45° FOV:
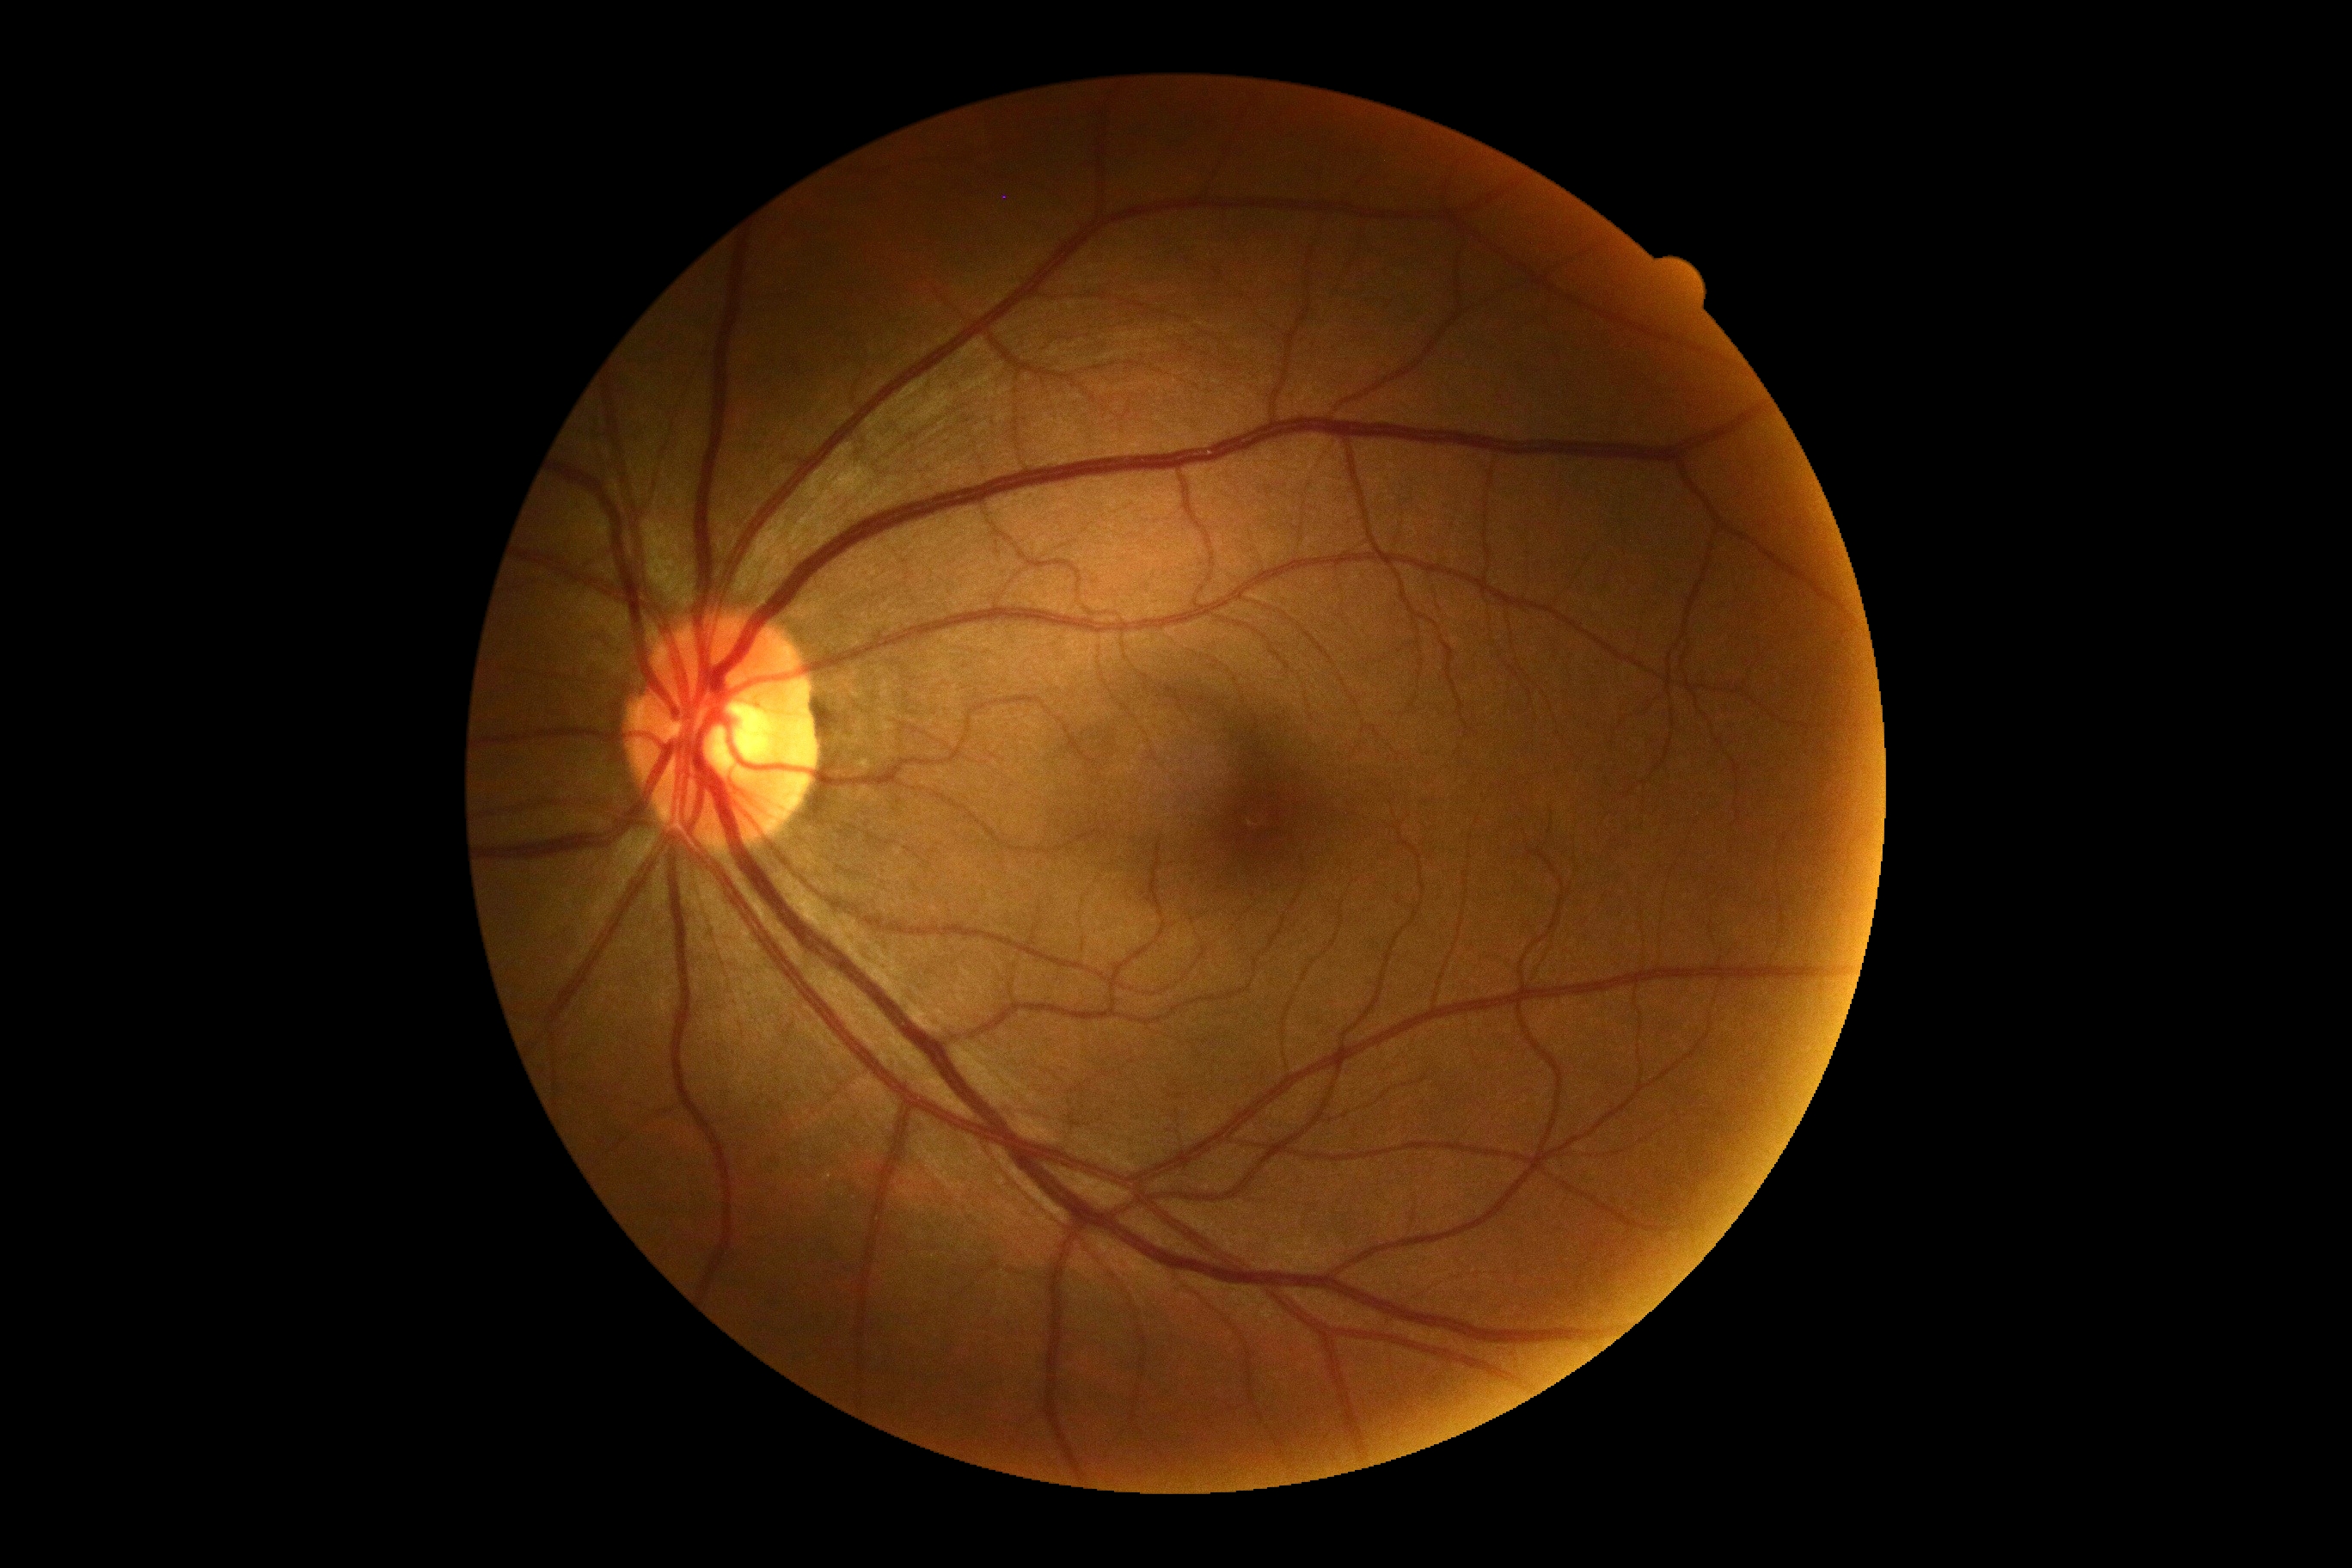 Annotations:
– diabetic retinopathy severity: grade 0 (no apparent retinopathy)